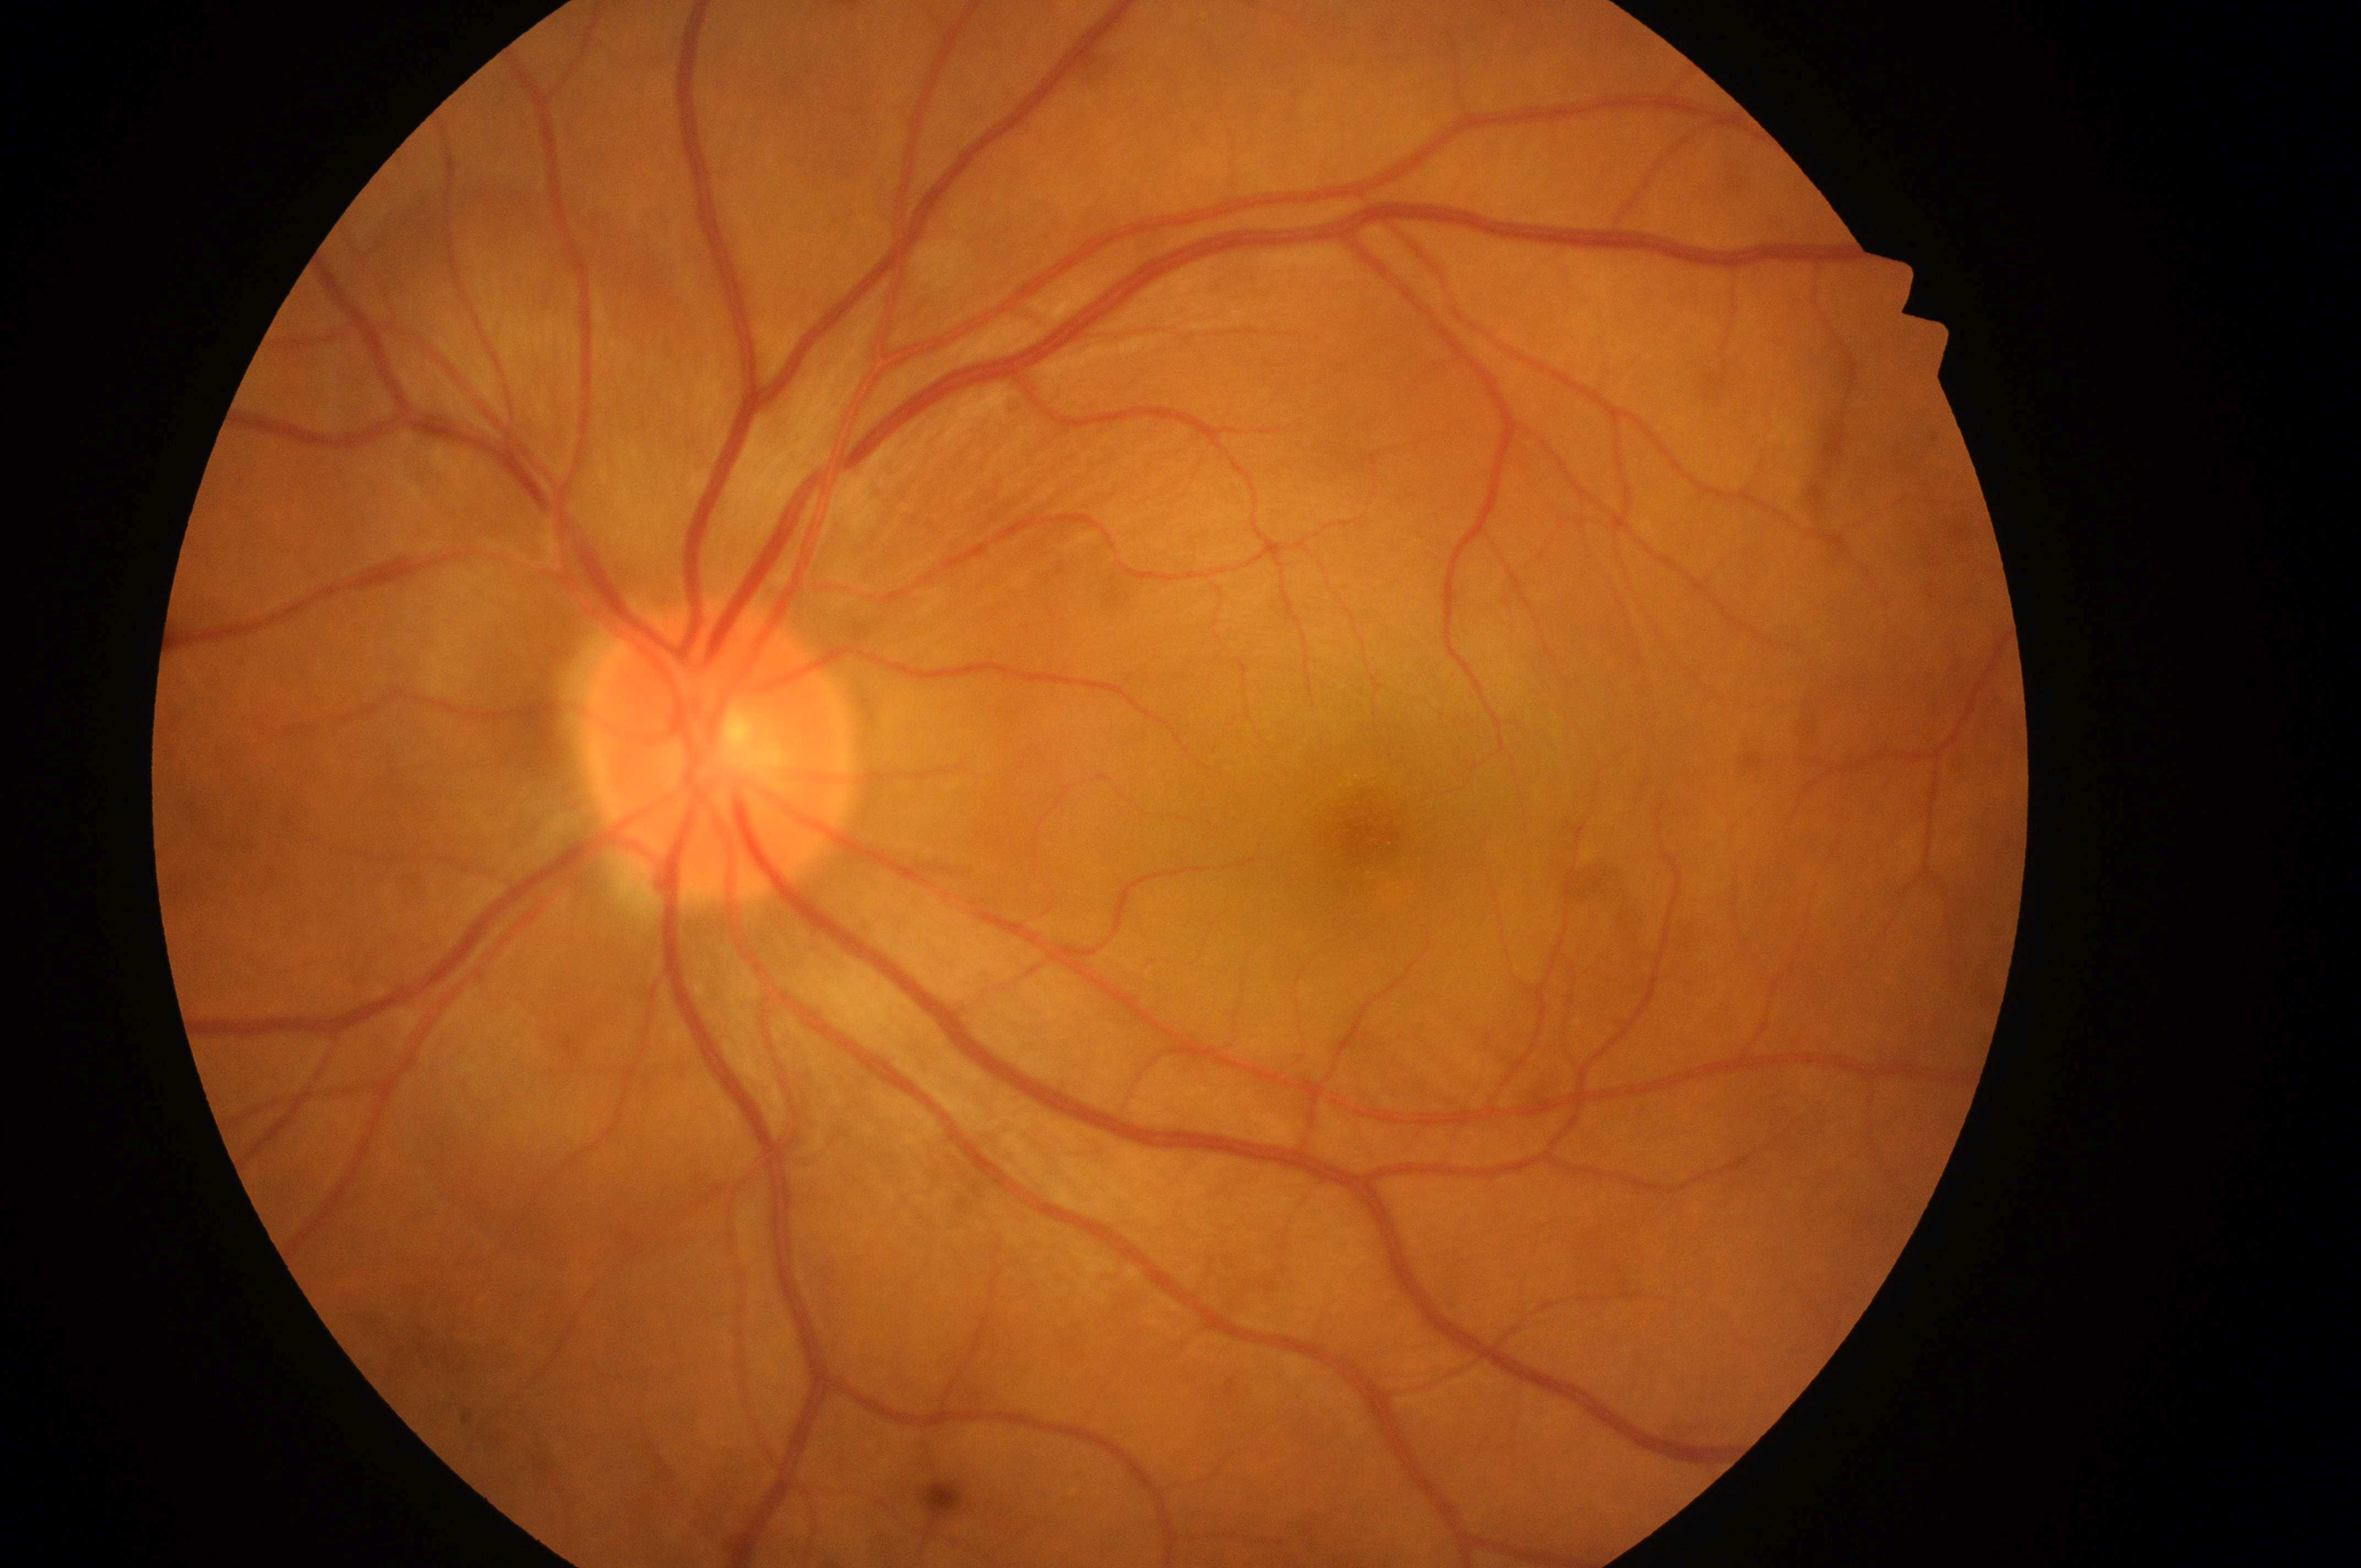 oculus sinister; No diabetic retinal disease findings; DR: grade 0 (no apparent retinopathy); optic nerve head: [717, 760]; DME: grade 0 (no risk); the fovea: [1369, 831].